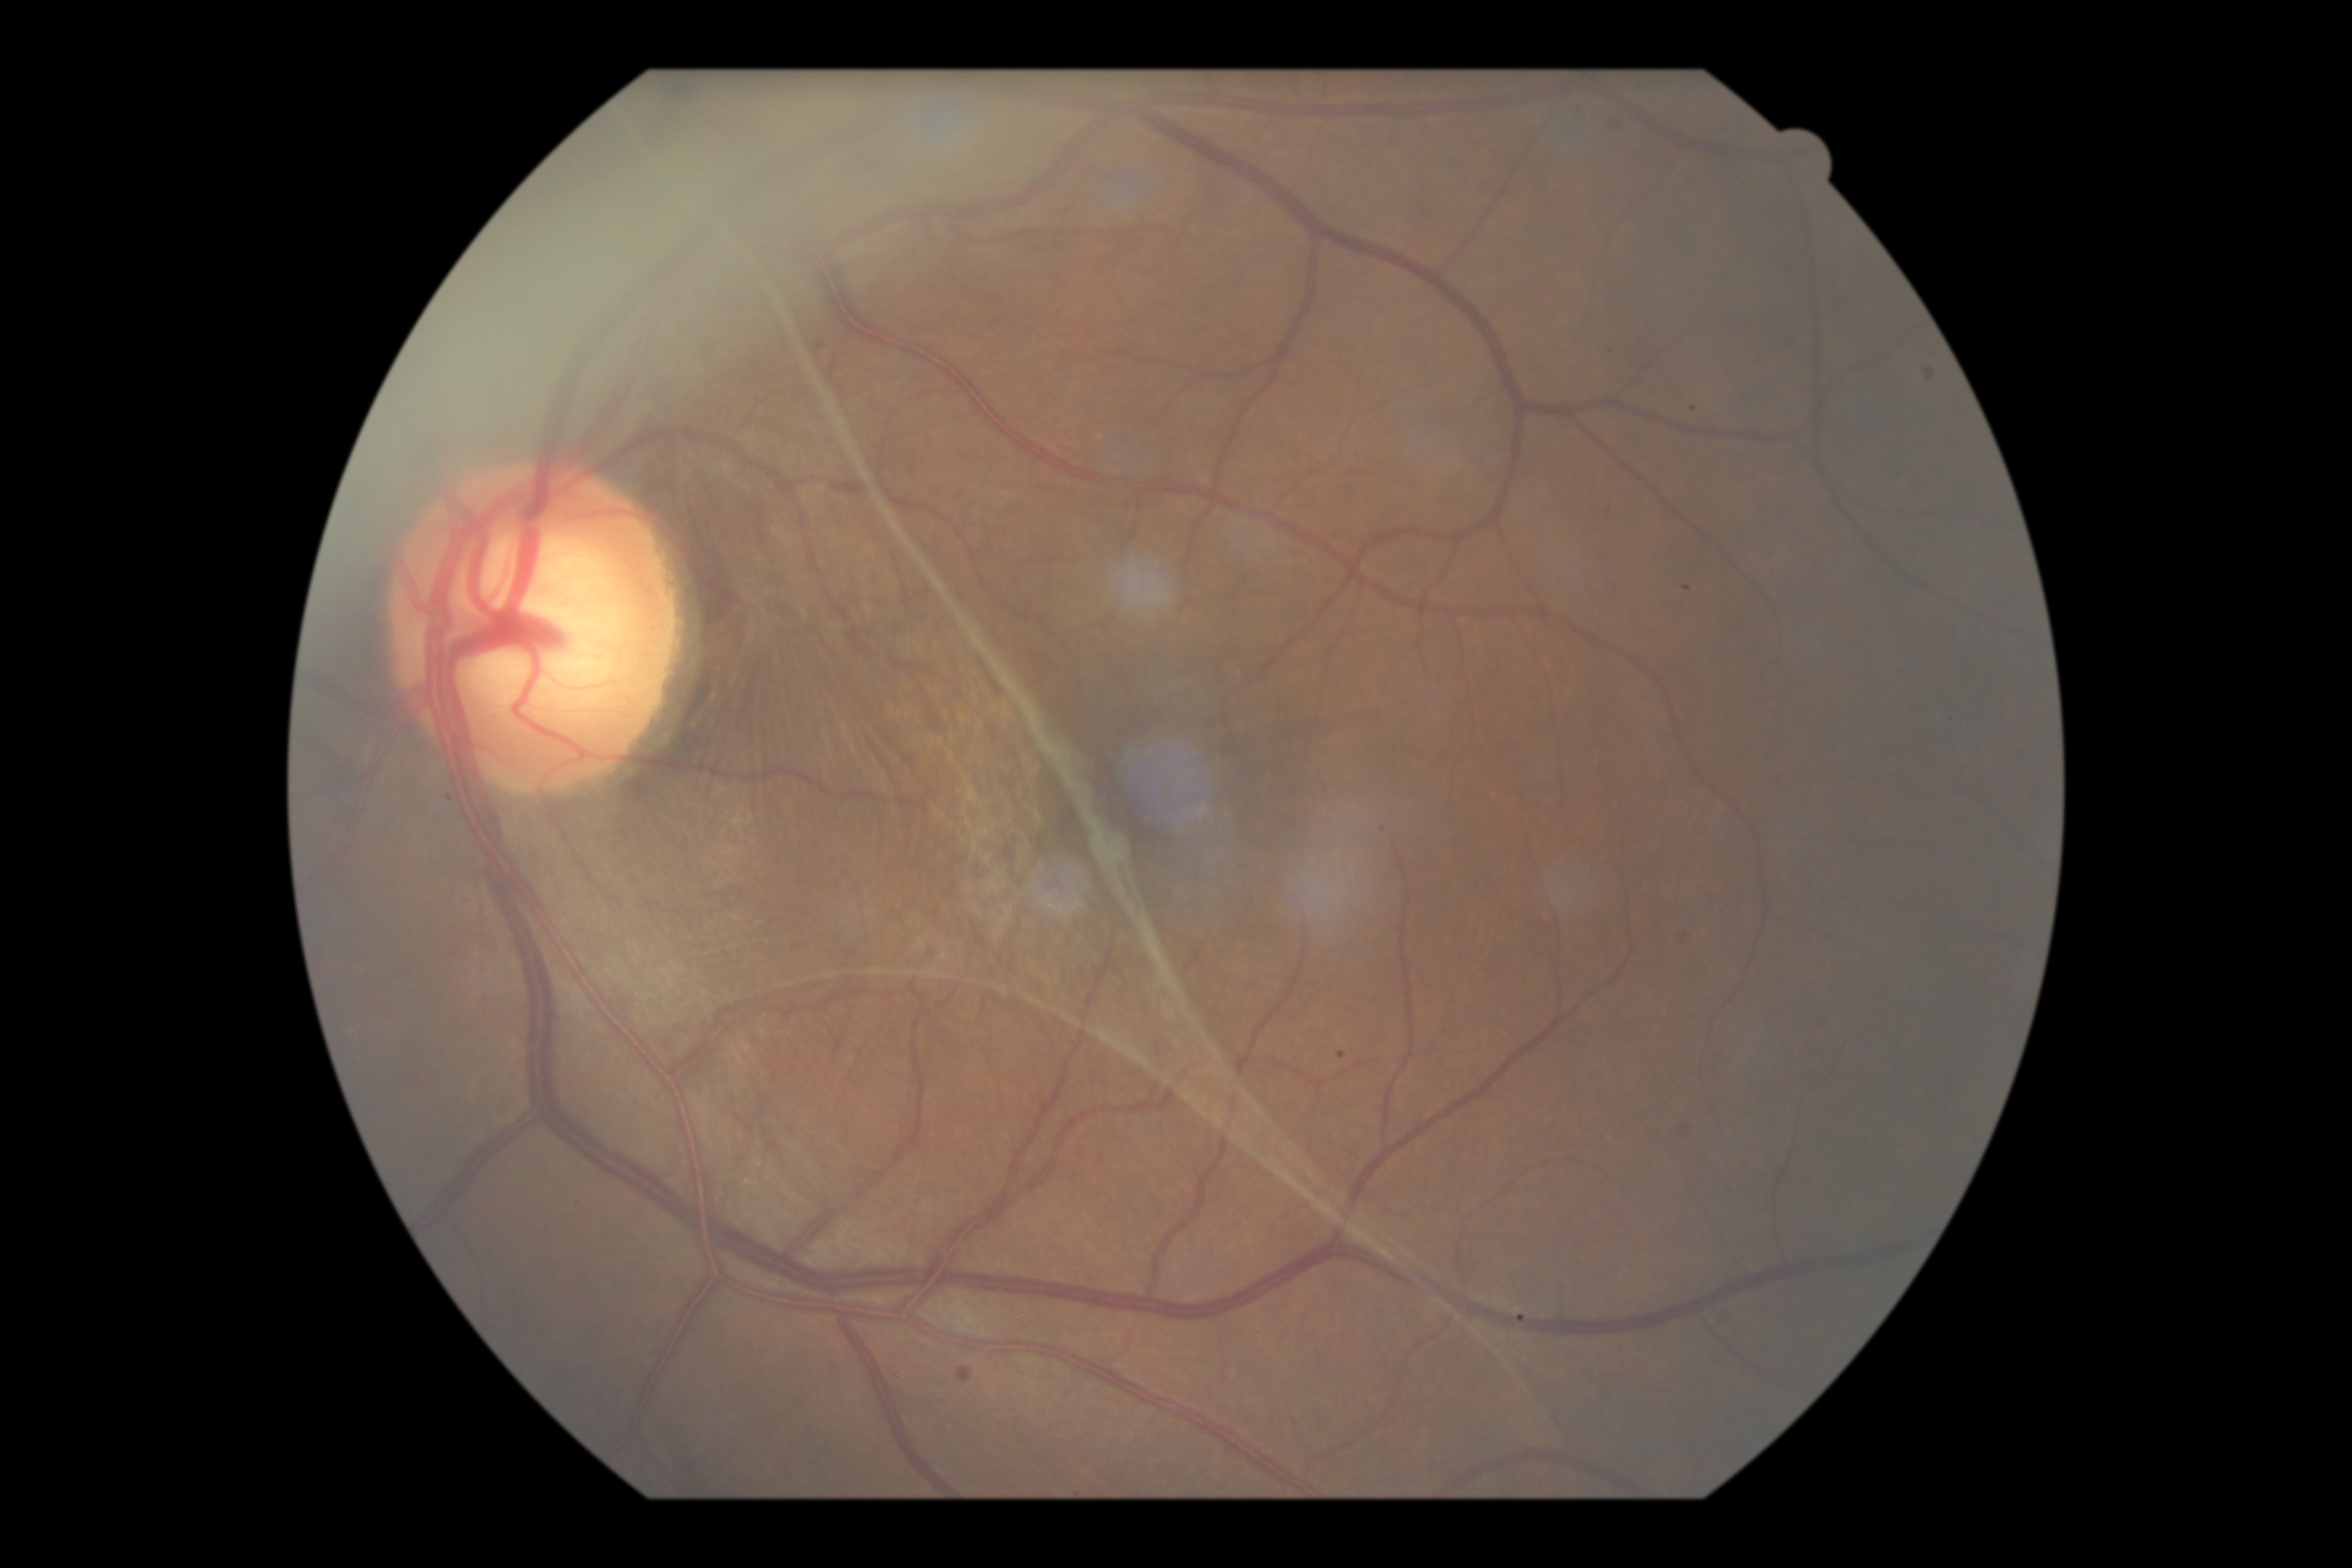
Retinopathy: PDR (grade 4). DR class: proliferative diabetic retinopathy.